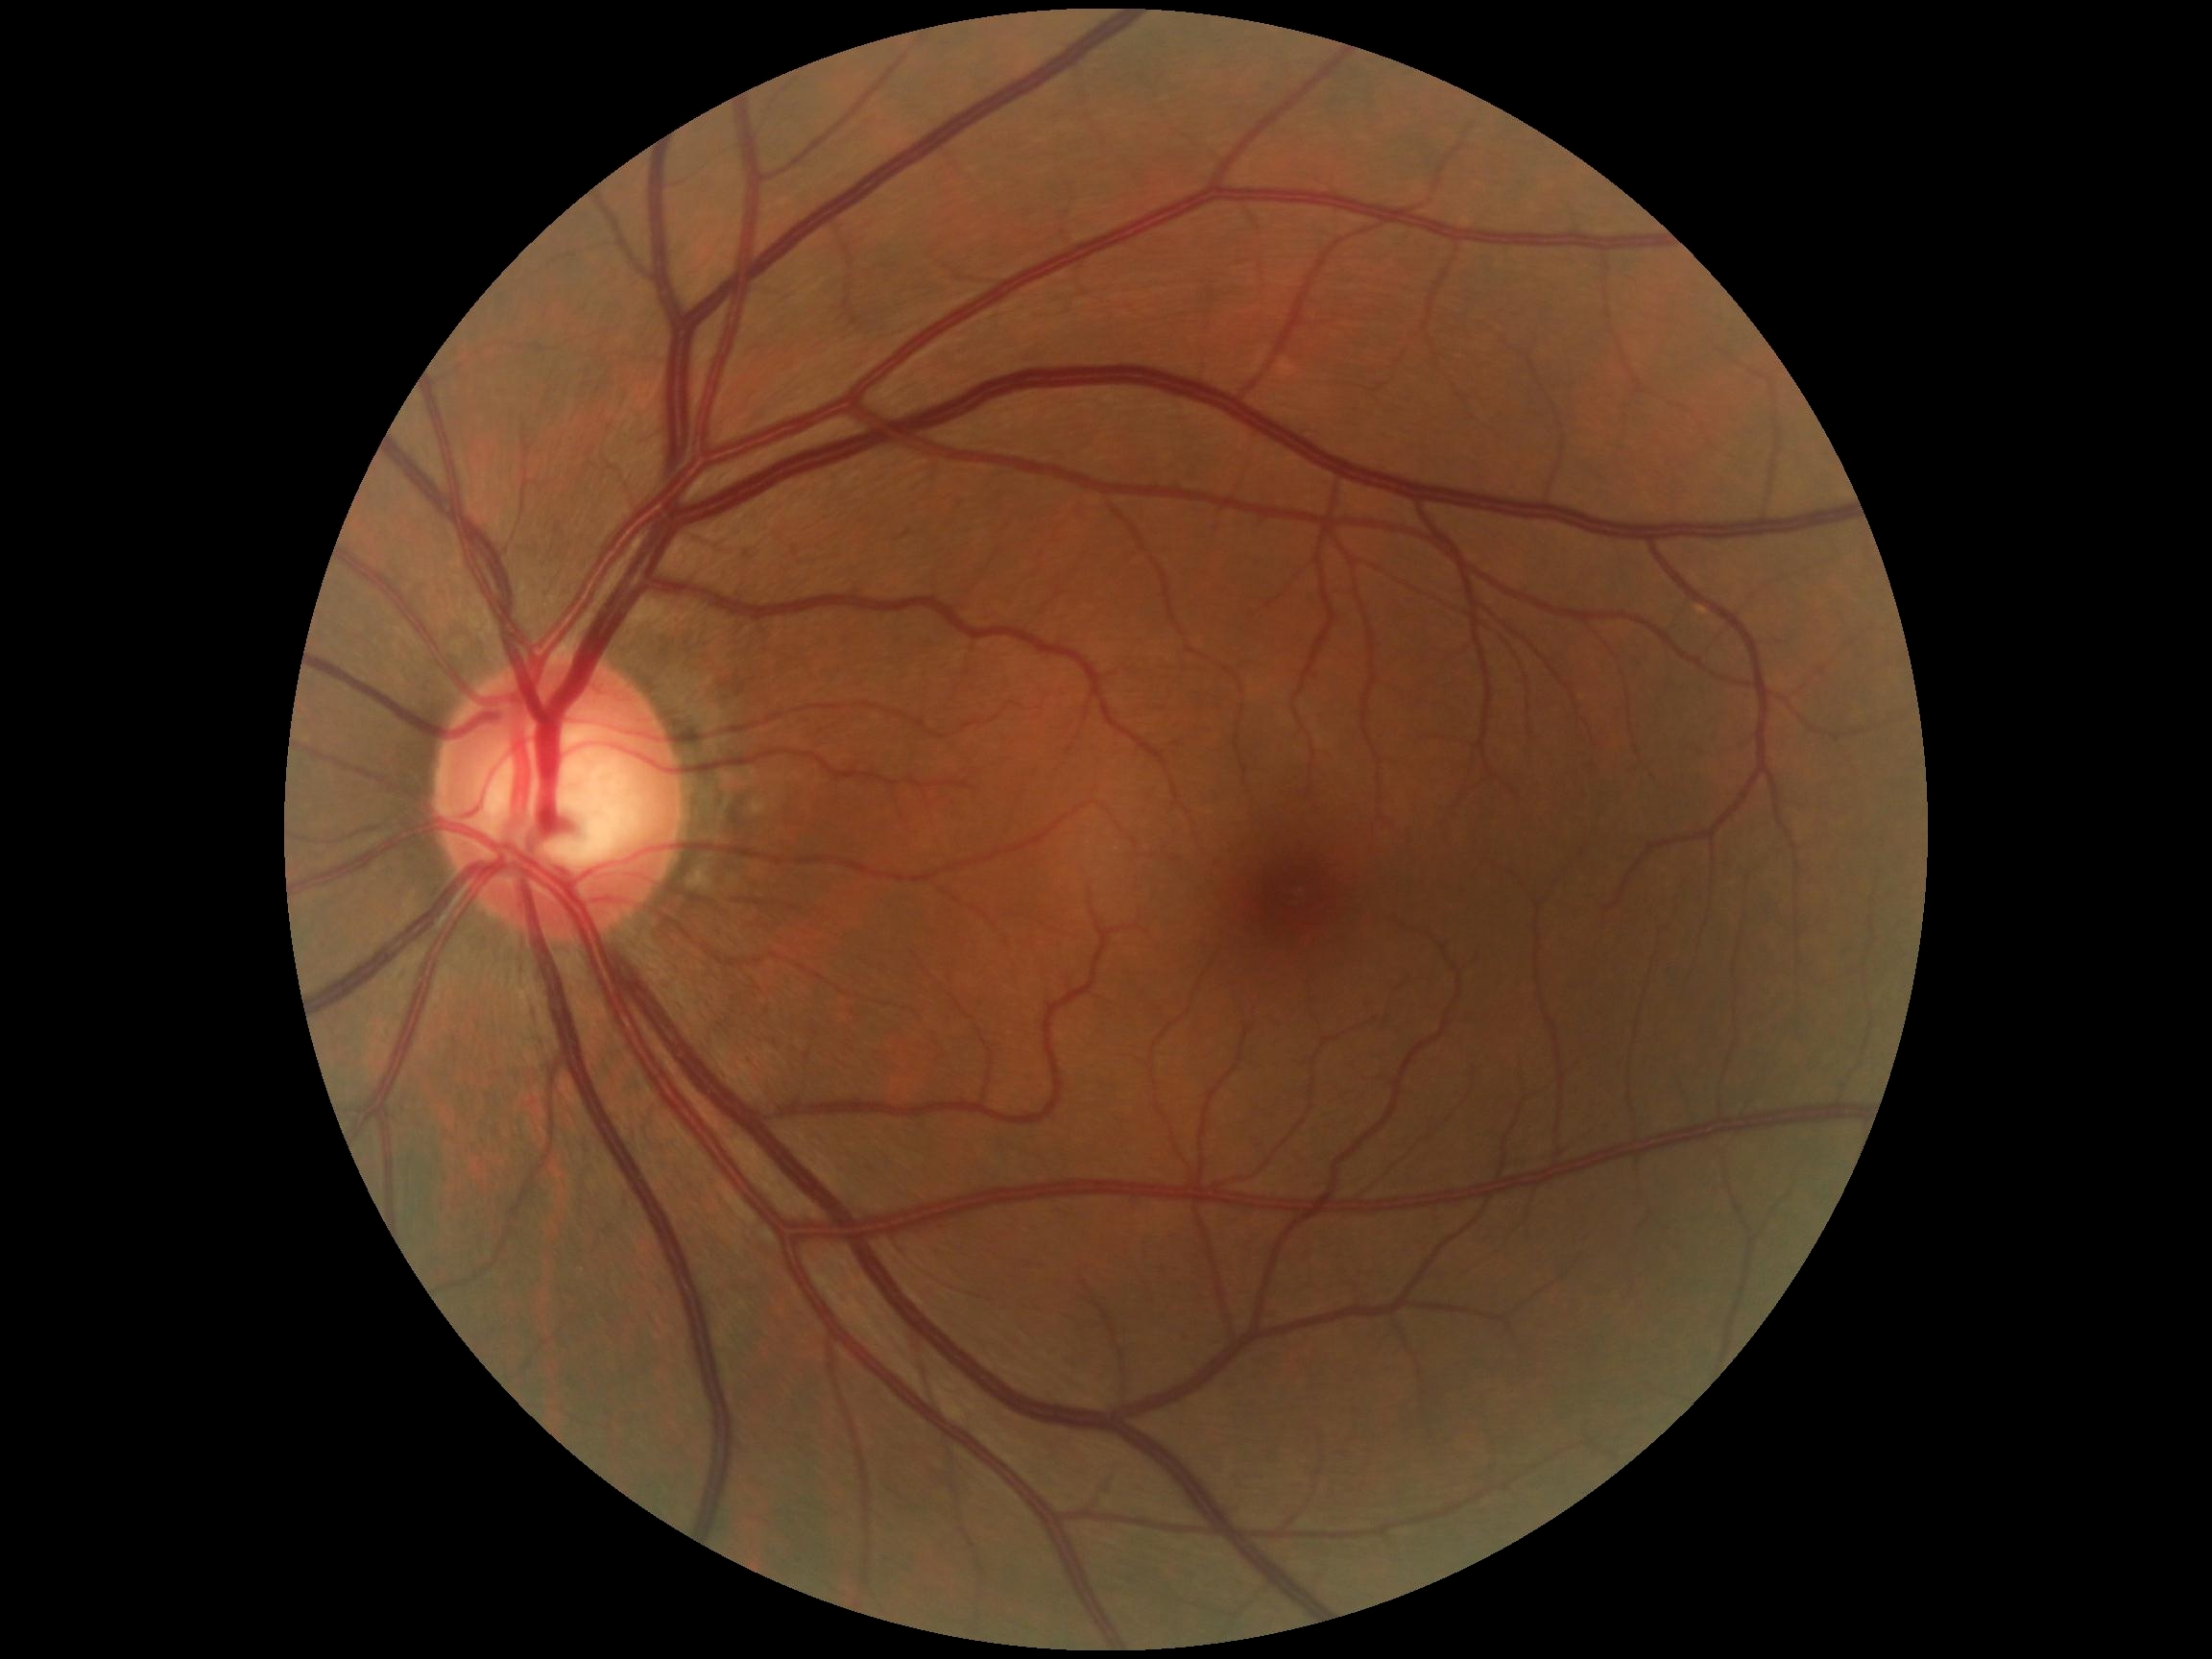 DR grade: 0/4. No signs of diabetic retinopathy.